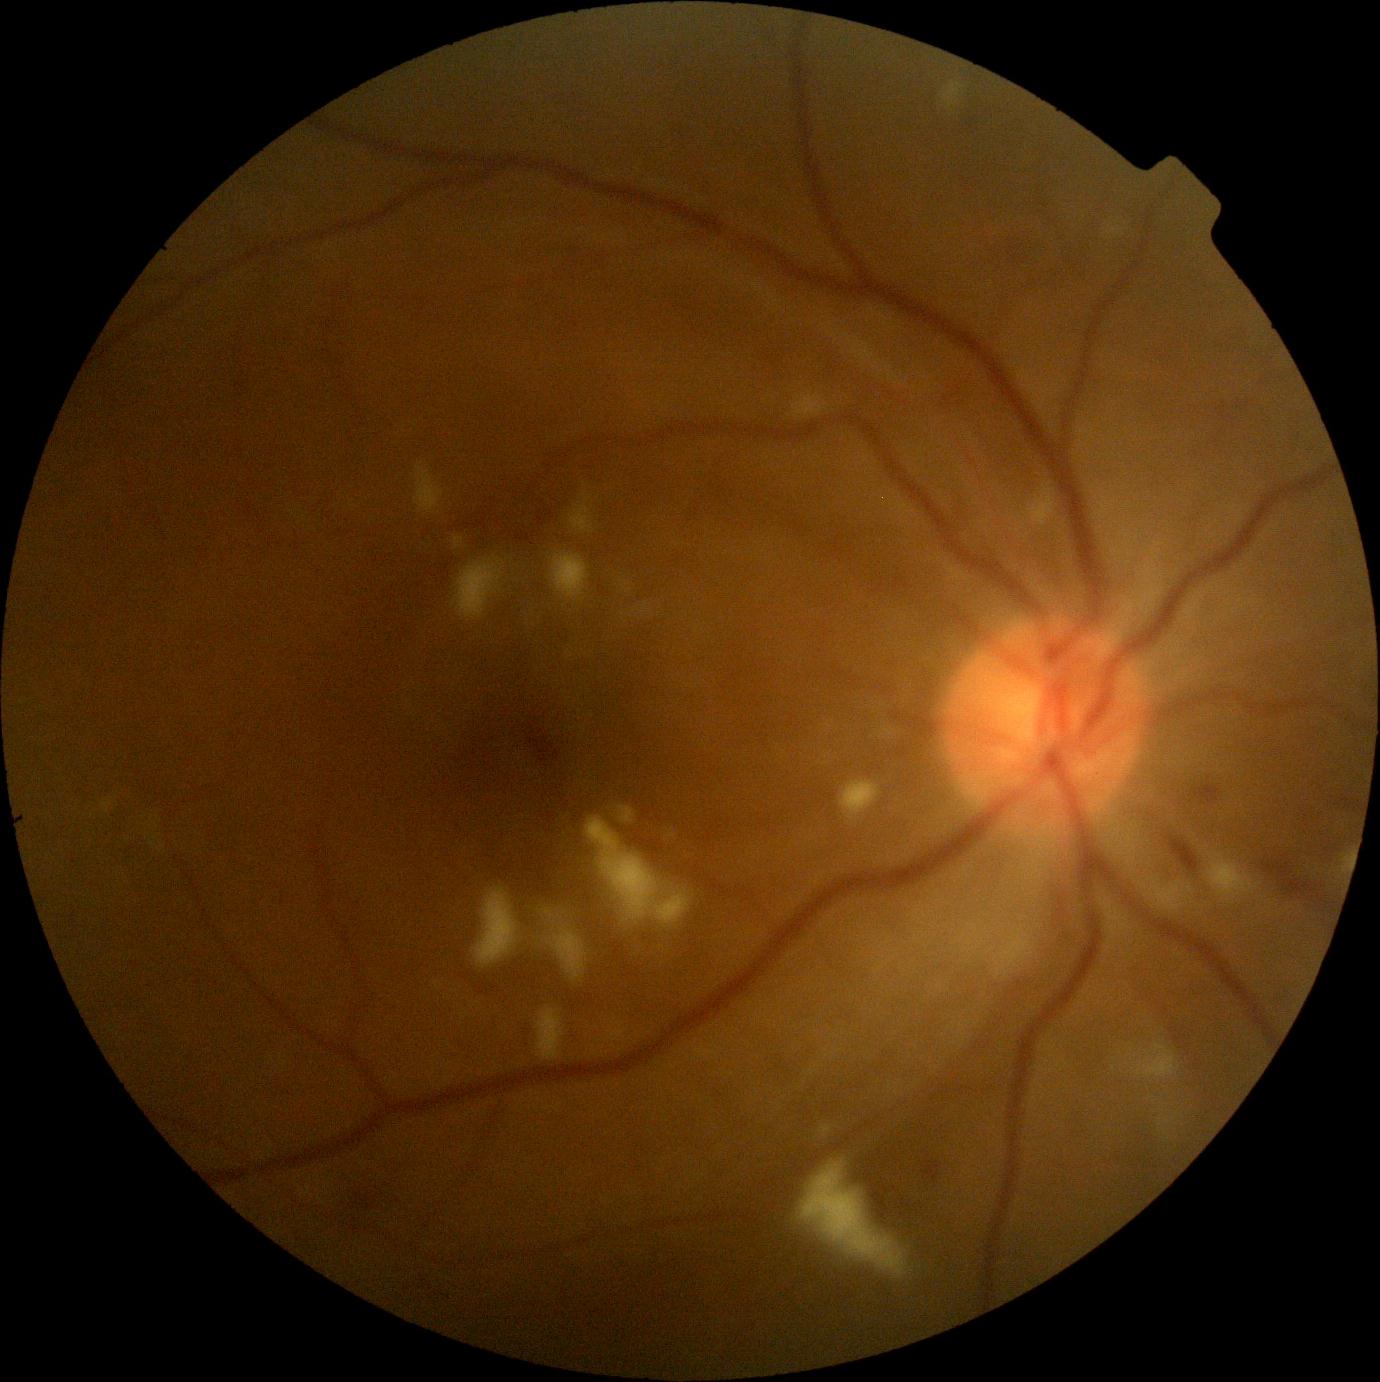
DR class=non-proliferative diabetic retinopathy; diabetic retinopathy (DR)=moderate non-proliferative diabetic retinopathy (grade 2) — more than just microaneurysms but less than severe NPDR.